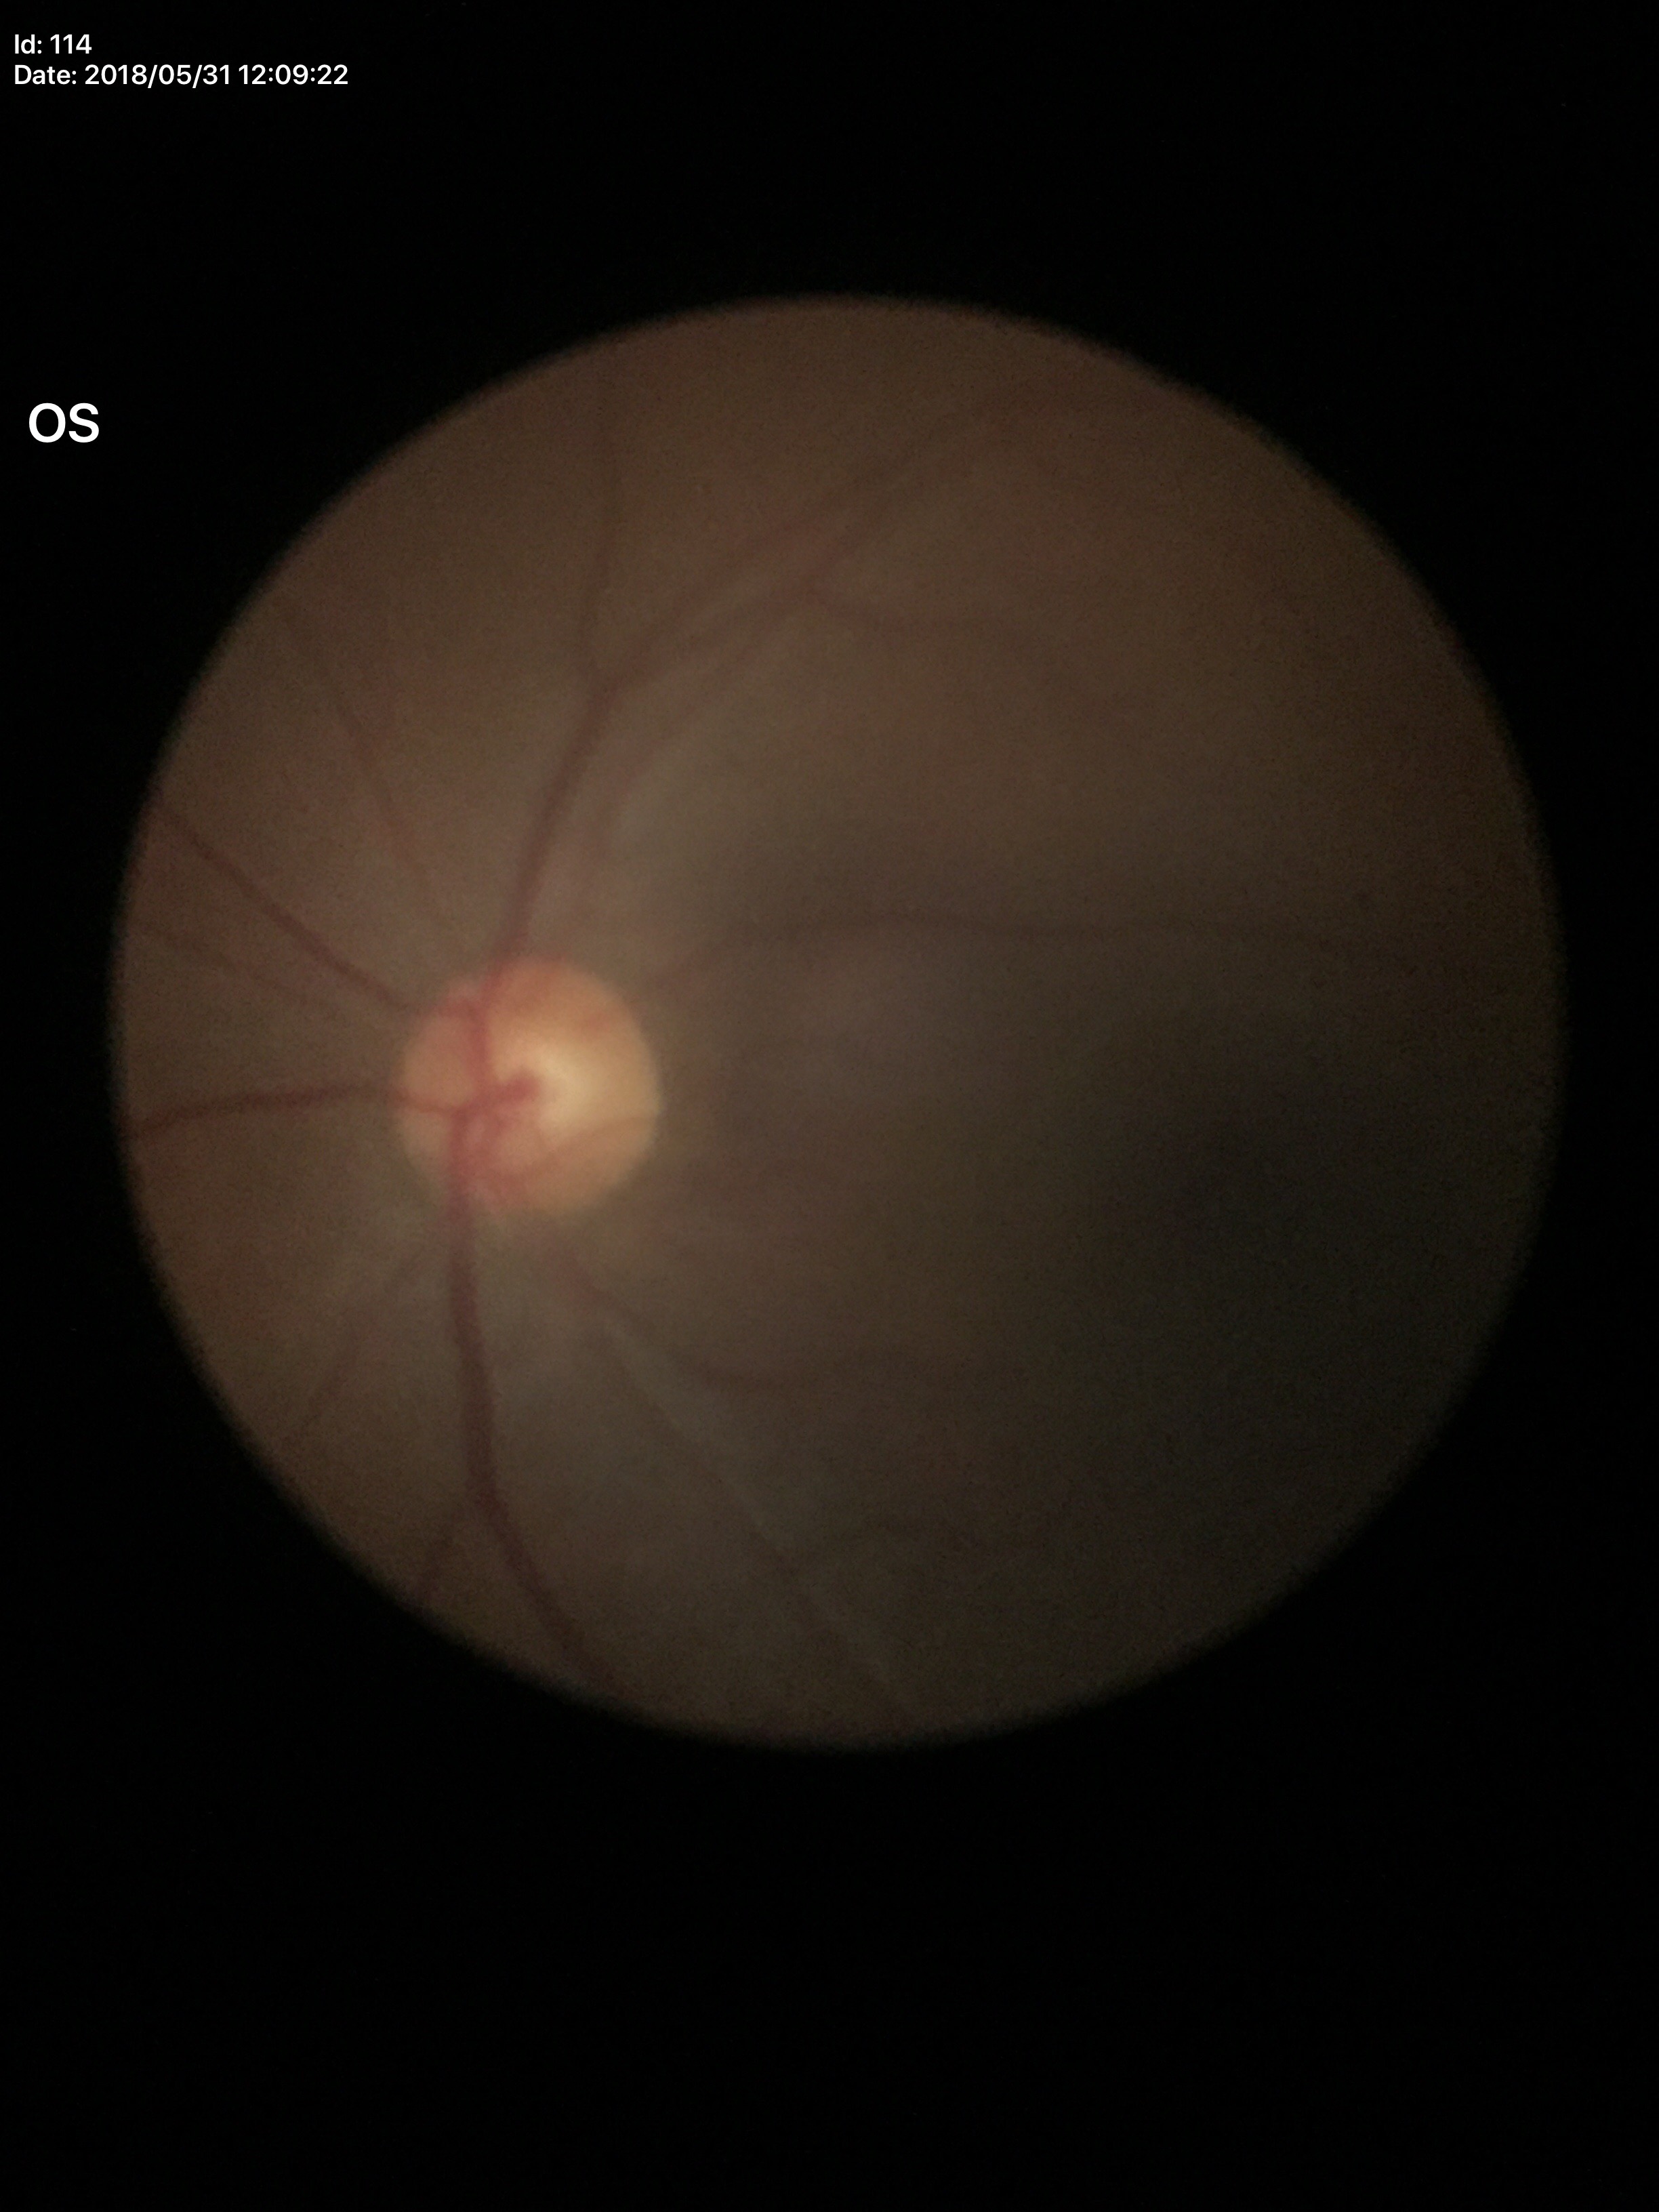

Horizontal C/D ratio is 0.53.
No evidence of glaucoma.
Vertical cup-disc ratio is 0.51.